2048 x 1536 pixels · color fundus photograph: 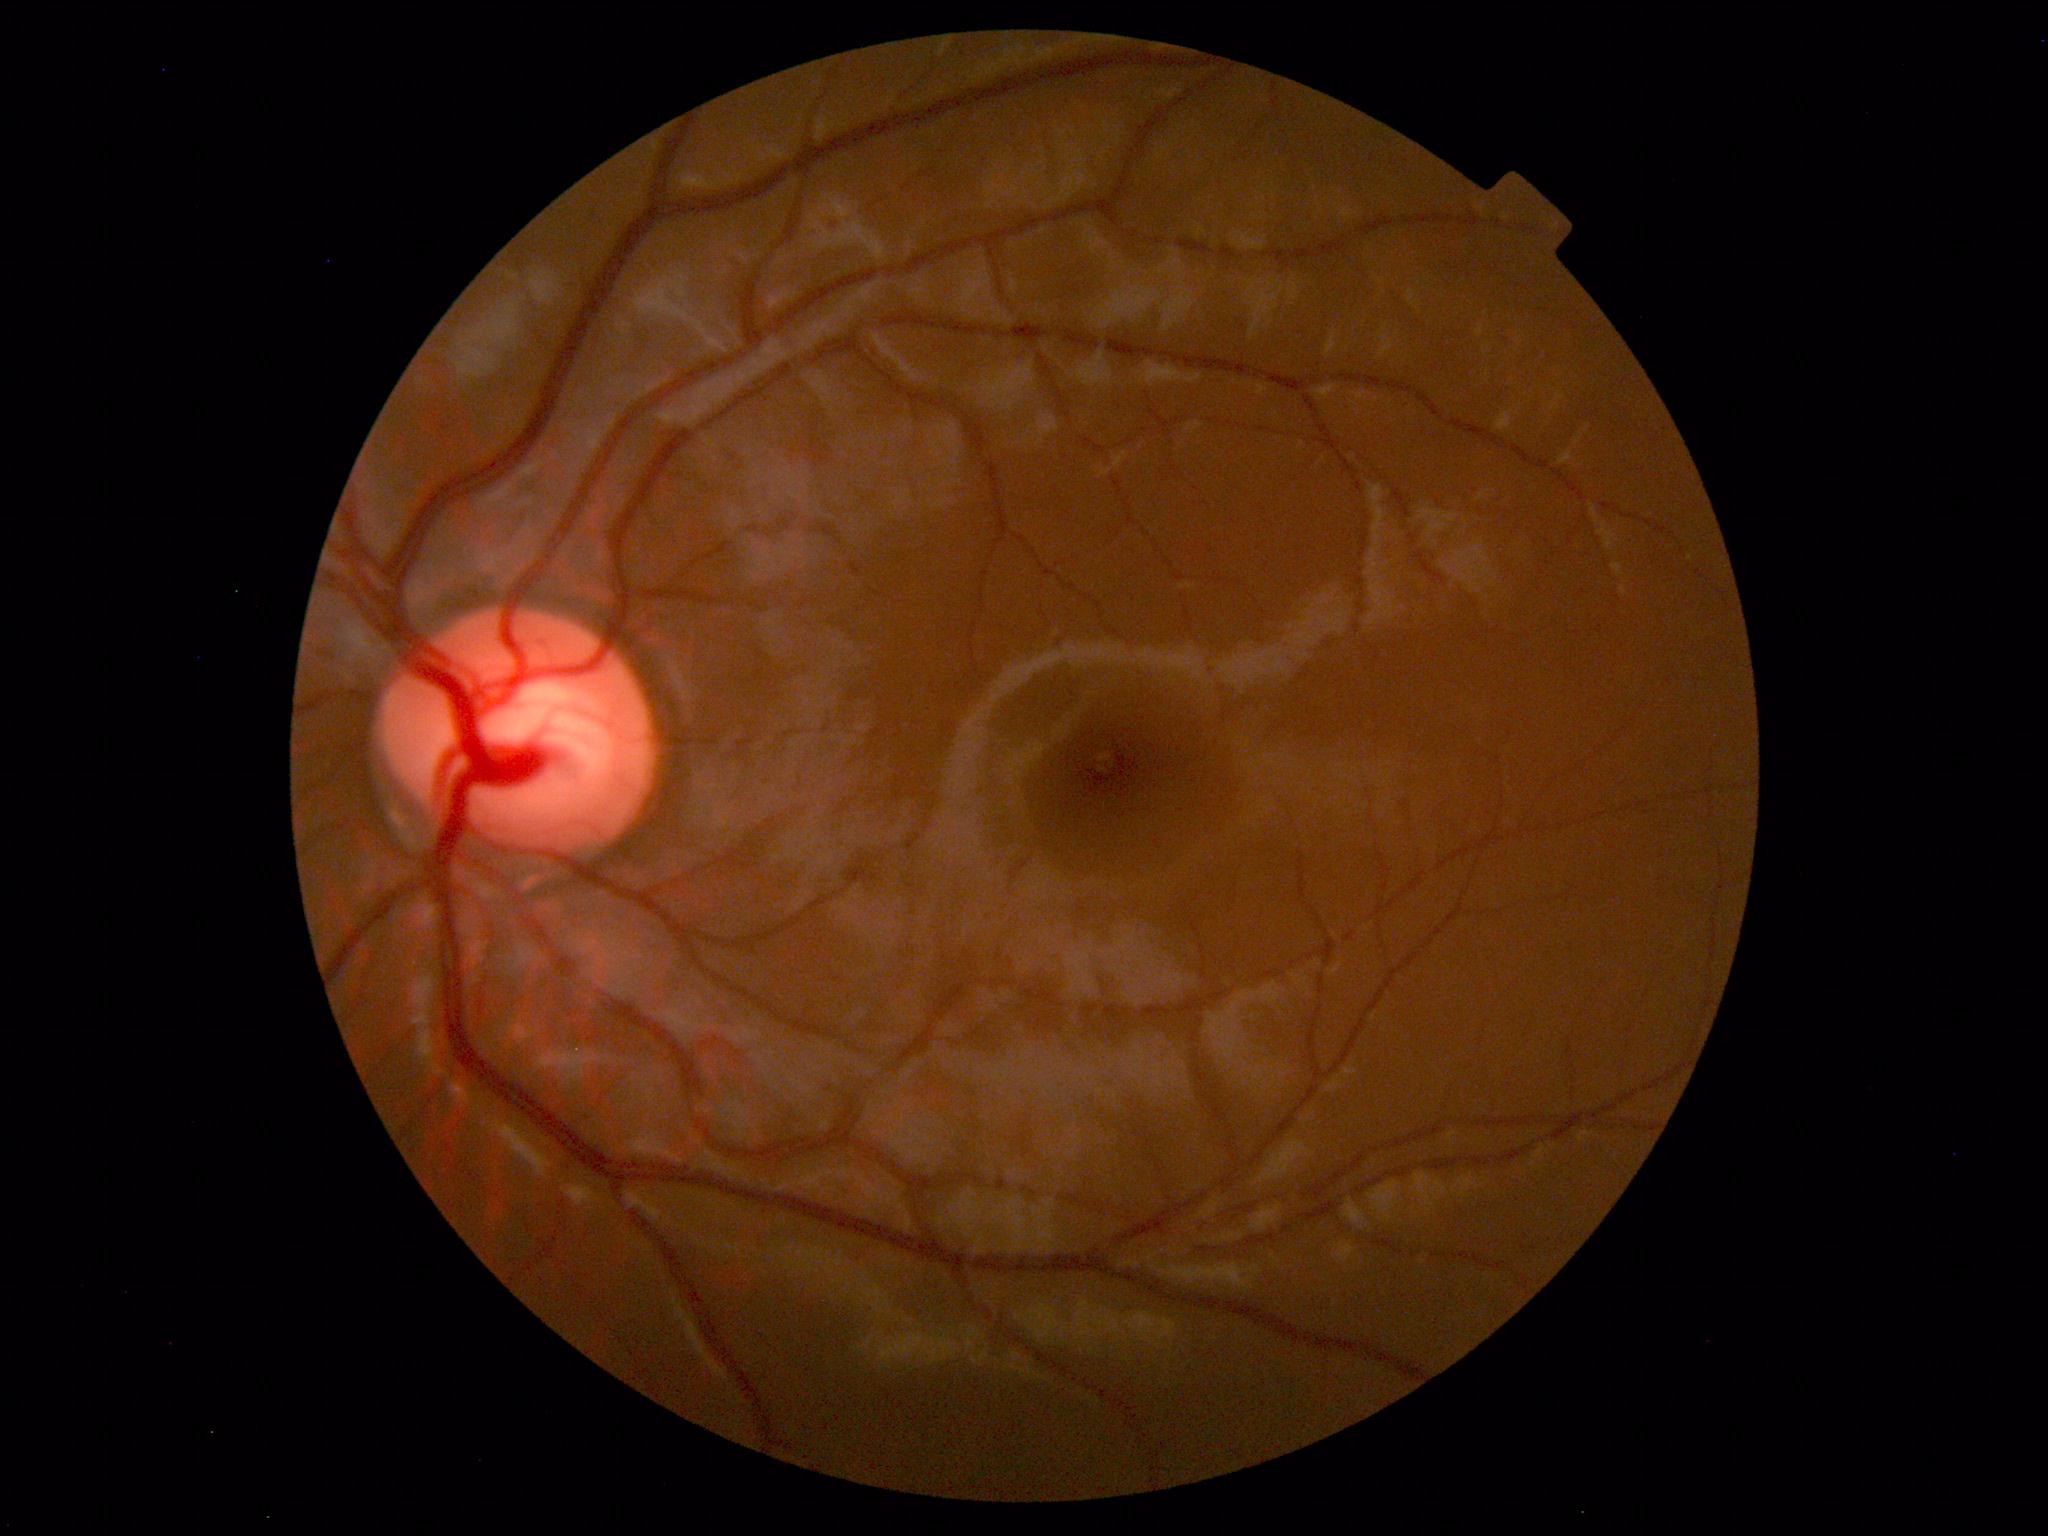 The fundus appears normal with no pathological findings.